2228 by 1652 pixels, mydriatic (tropicamide and phenylephrine) — 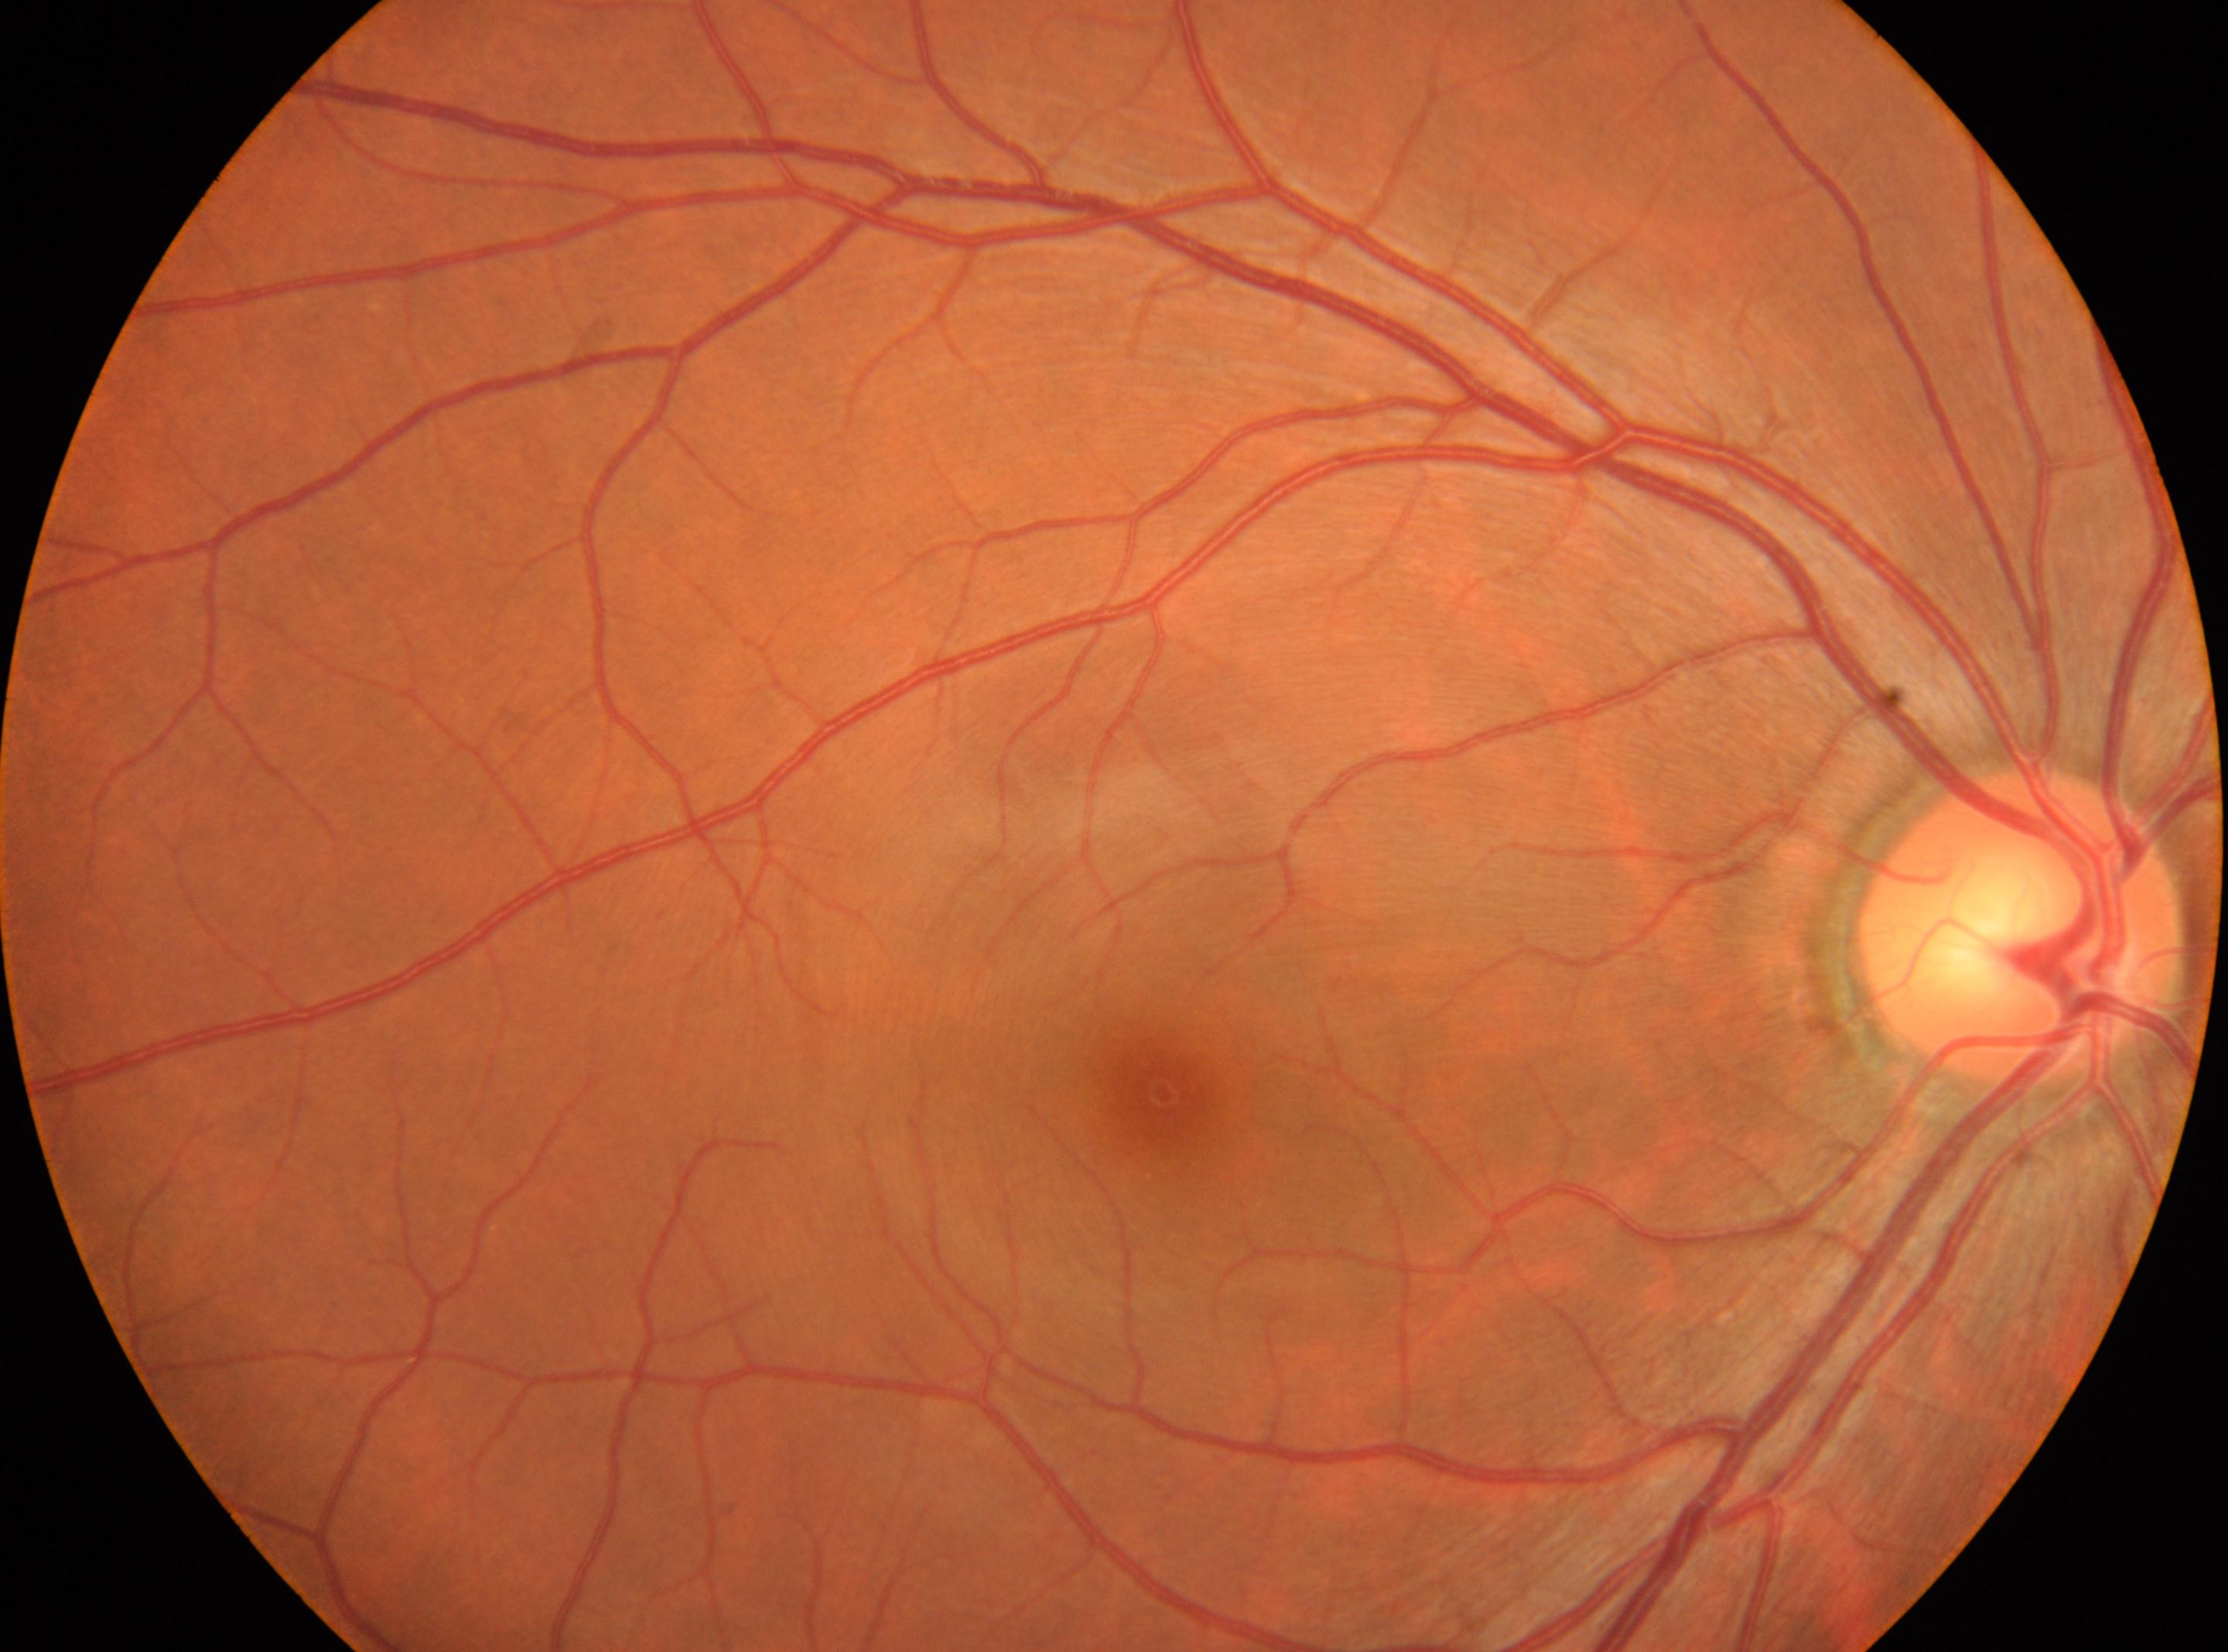
Eye: right eye. Fovea: (1164,1094). ONH located at (2018,923). DR stage is no apparent retinopathy (grade 0).